Image size 2352x1568 · retinal fundus photograph · 45° field of view — 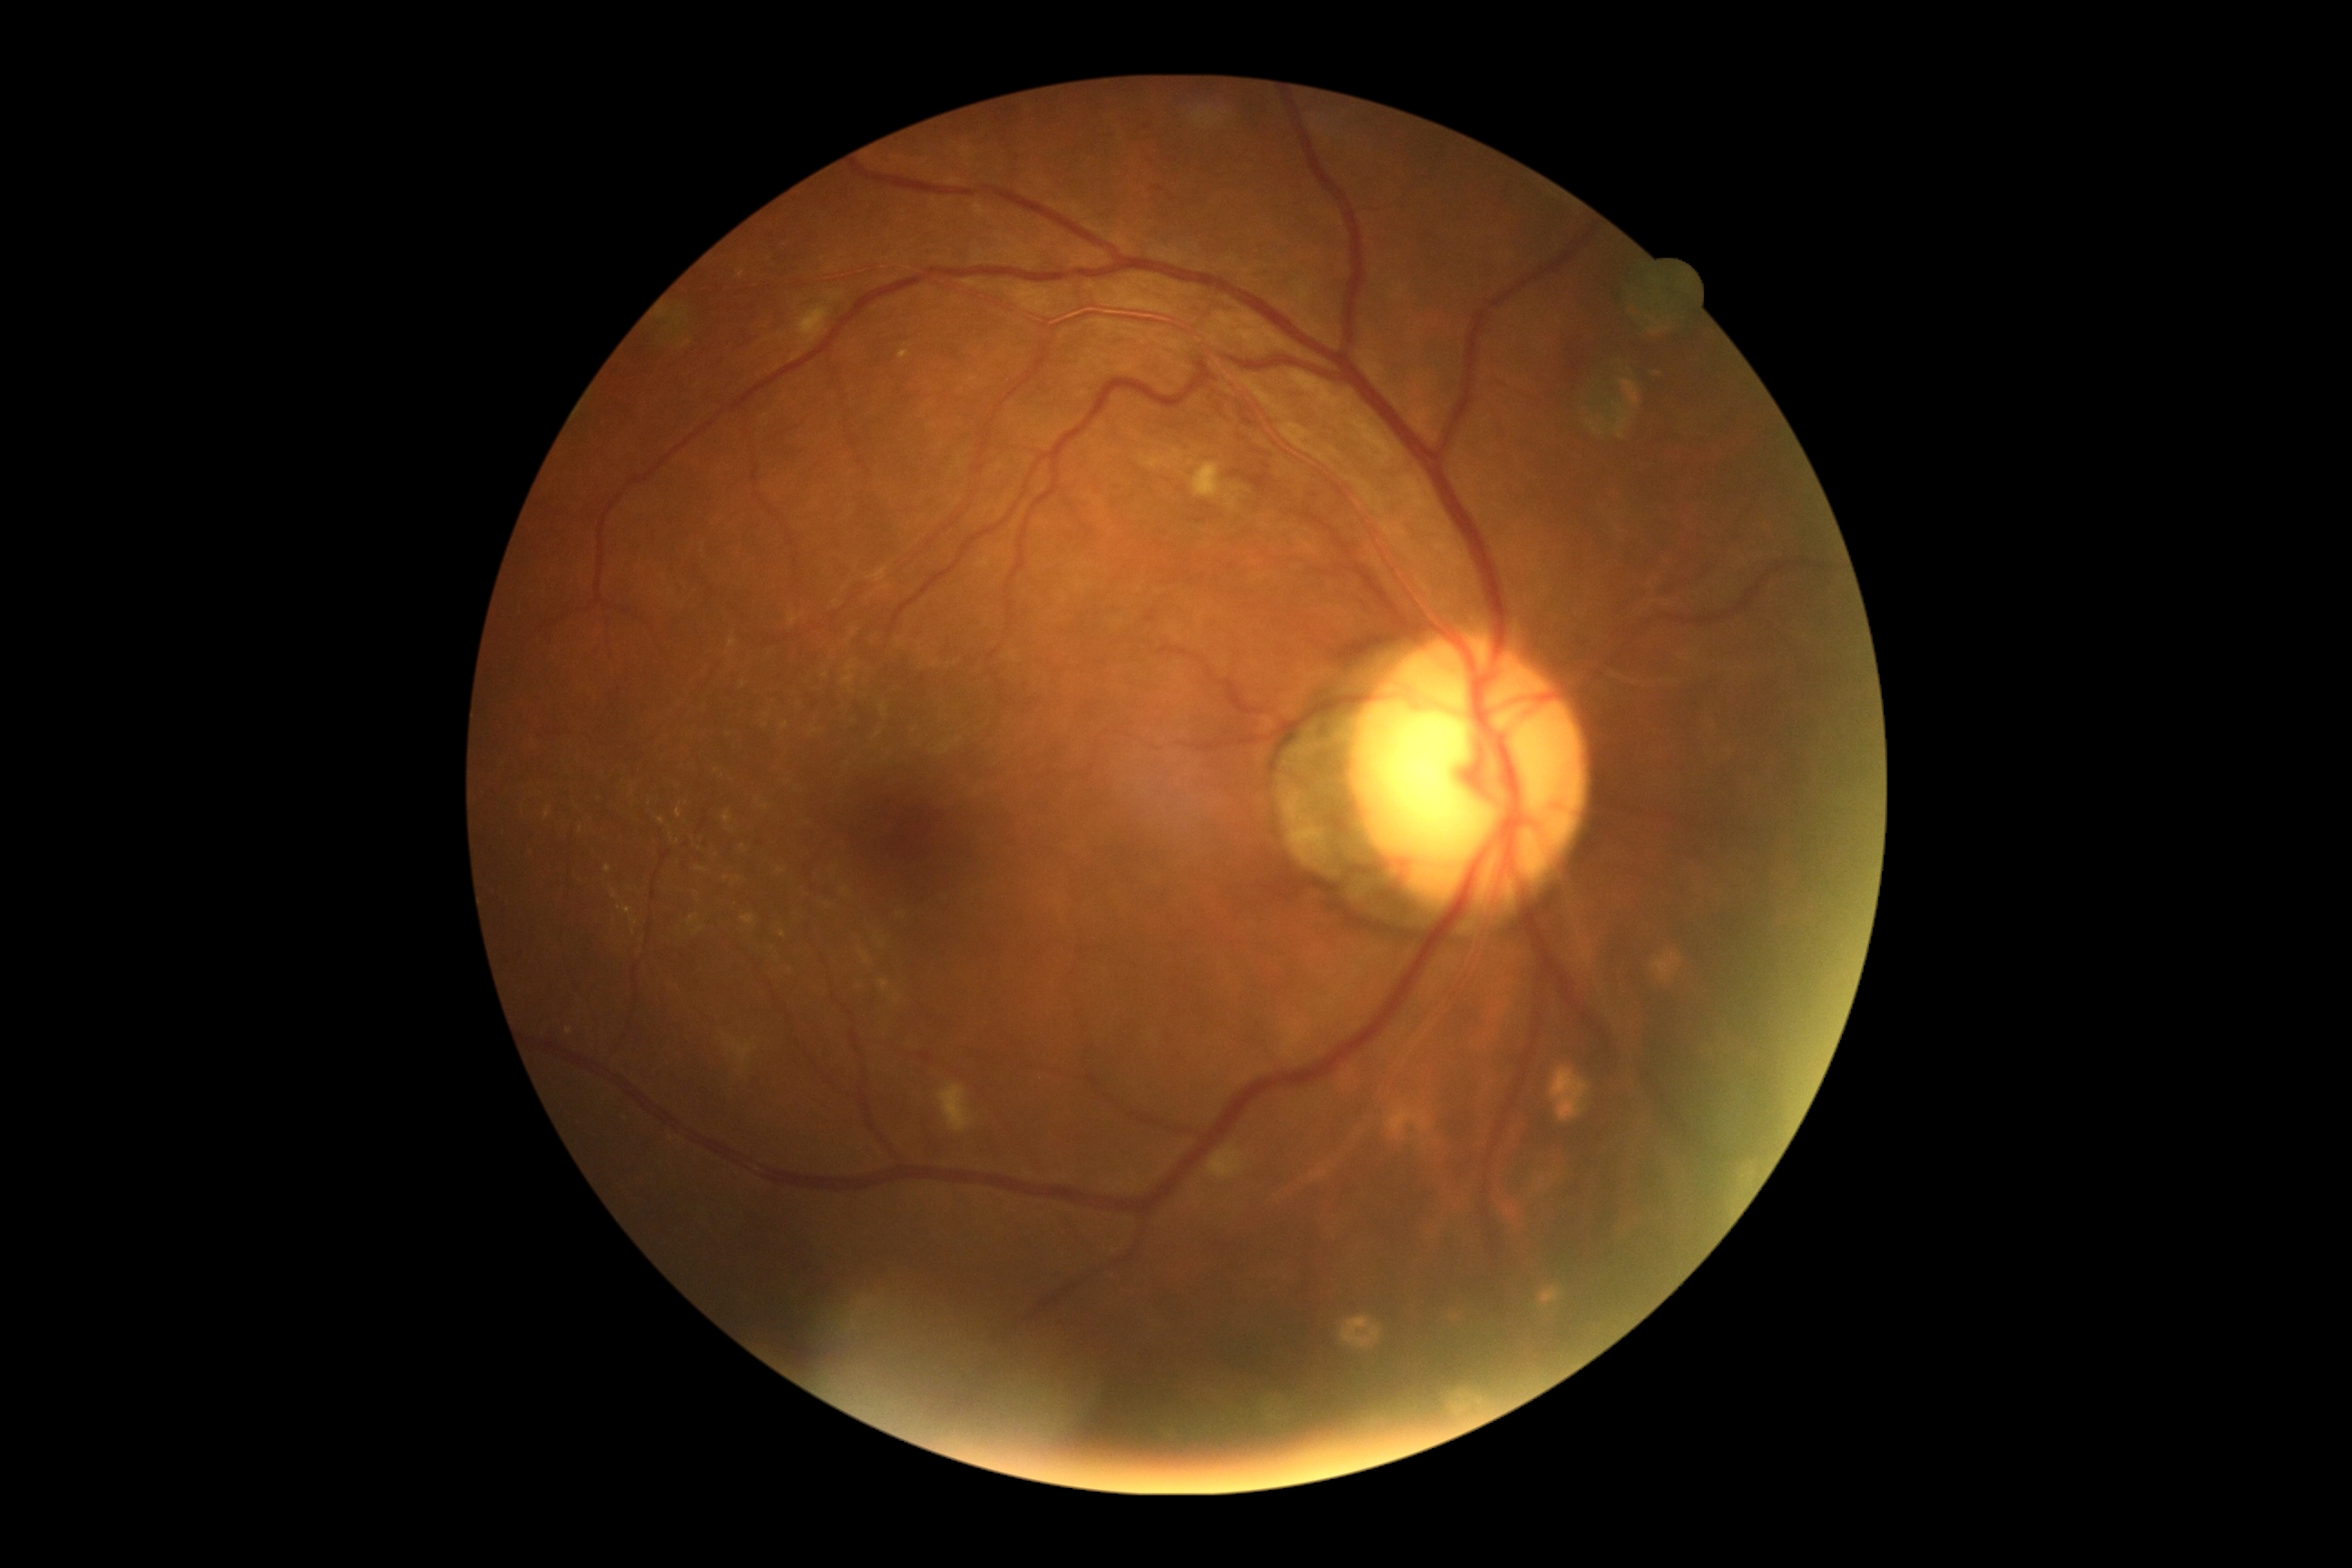

Retinopathy: moderate non-proliferative diabetic retinopathy (grade 2).